No pharmacologic dilation
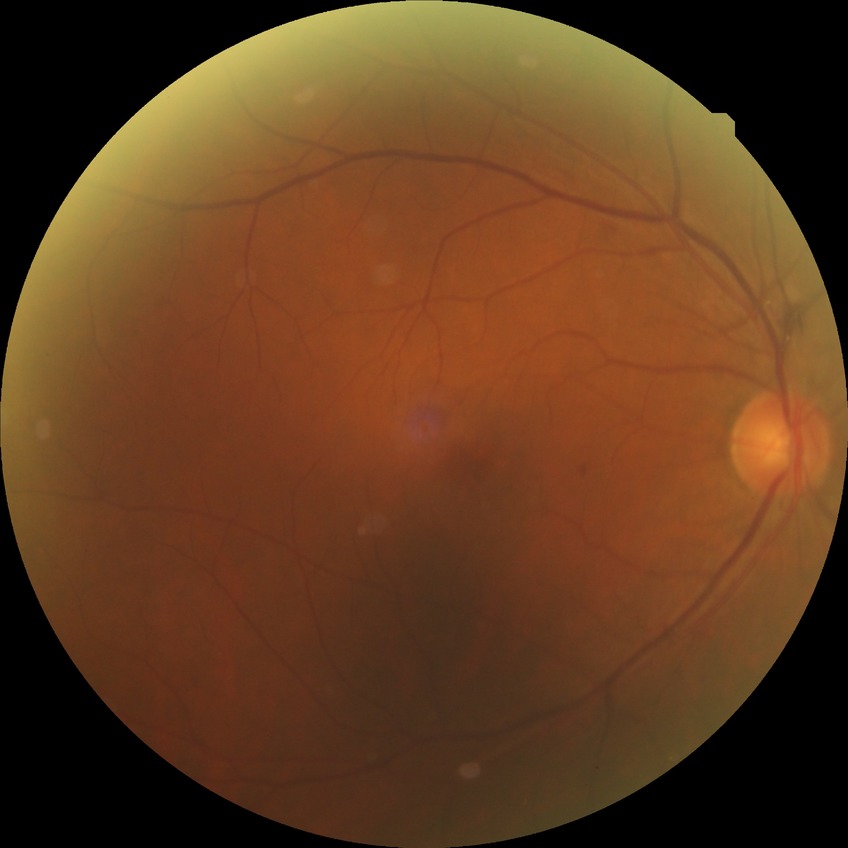
Davis grade: SDR.